45° FOV · 2352 by 1568 pixels — 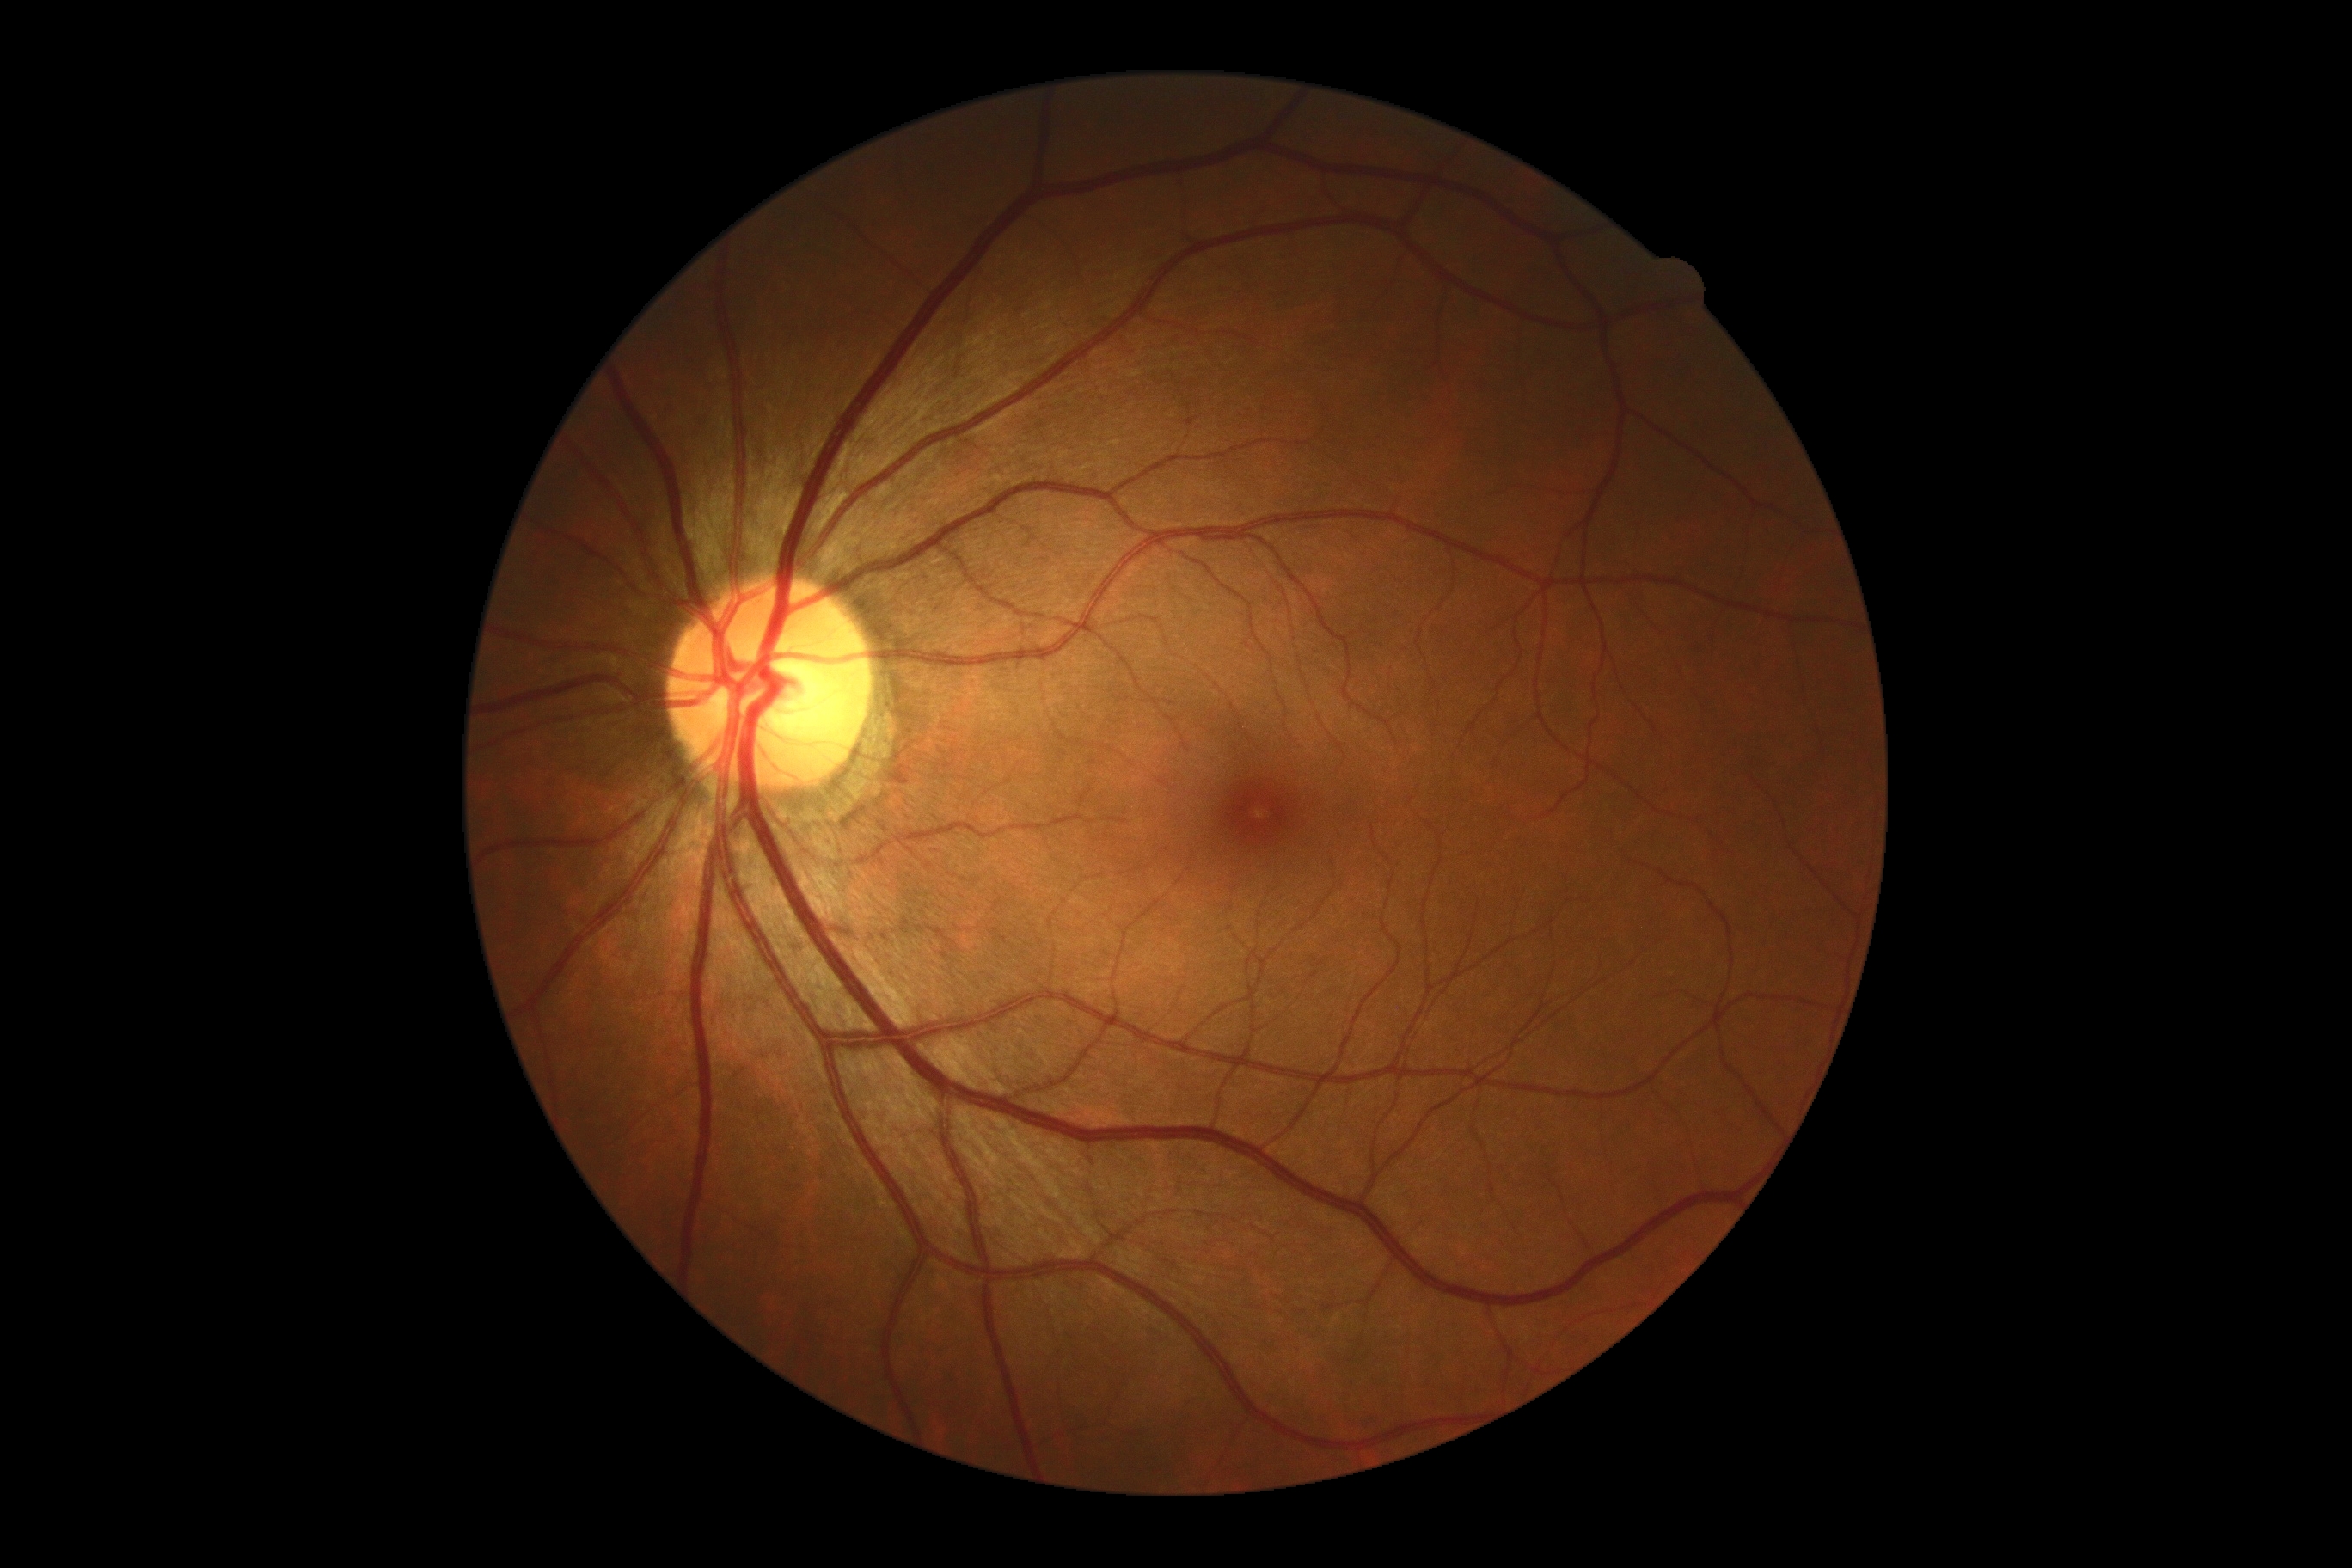

Retinopathy grade: 0 (no apparent retinopathy) — no visible signs of diabetic retinopathy.
No apparent diabetic retinopathy.